Phoenix ICON, 100° FOV. 1240x1240px. Phoenix ICON wide-field infant fundus image
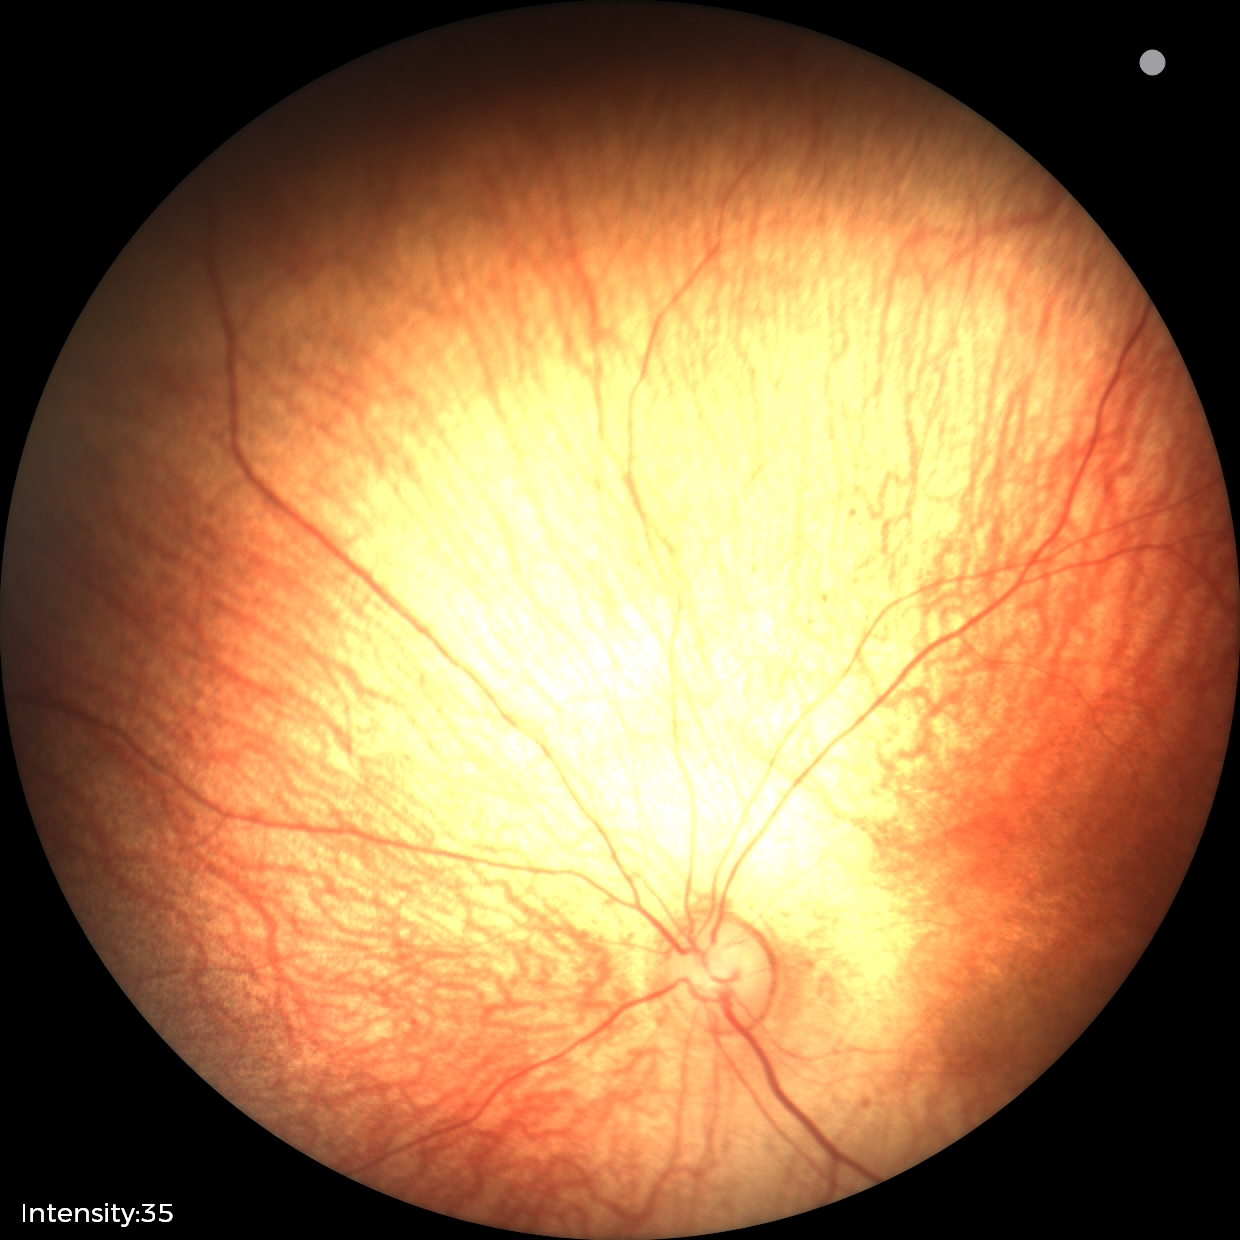 Assessment: physiological appearance with no retinal pathology.